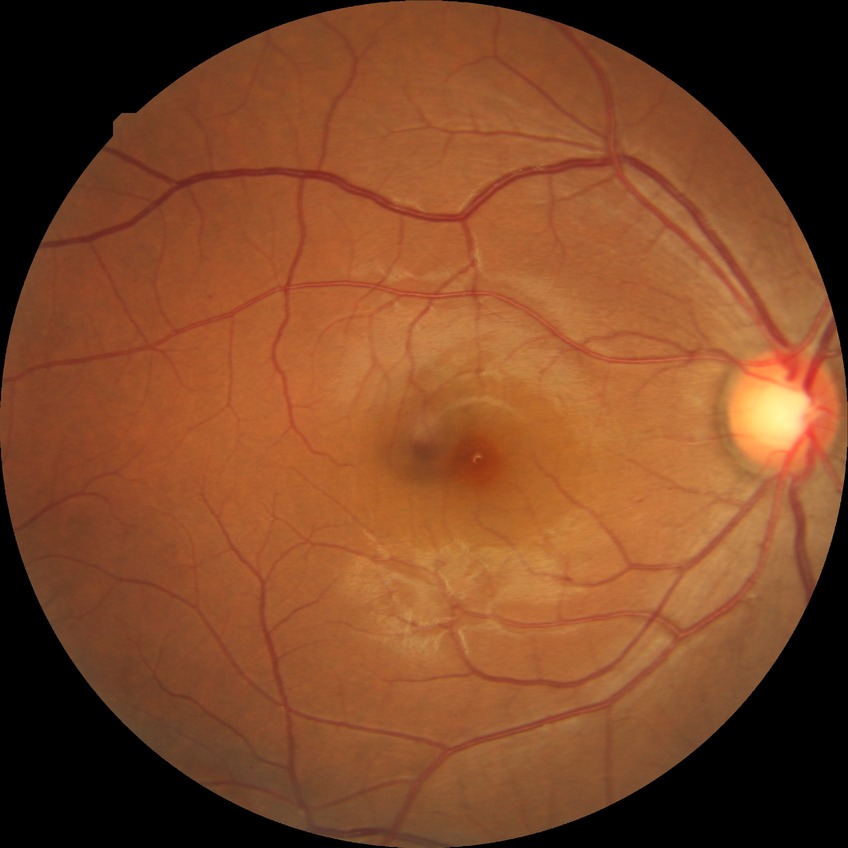
DR grade: SDR. Disease class: non-proliferative diabetic retinopathy.